Image size 2212x1659. FOV: 45 degrees: 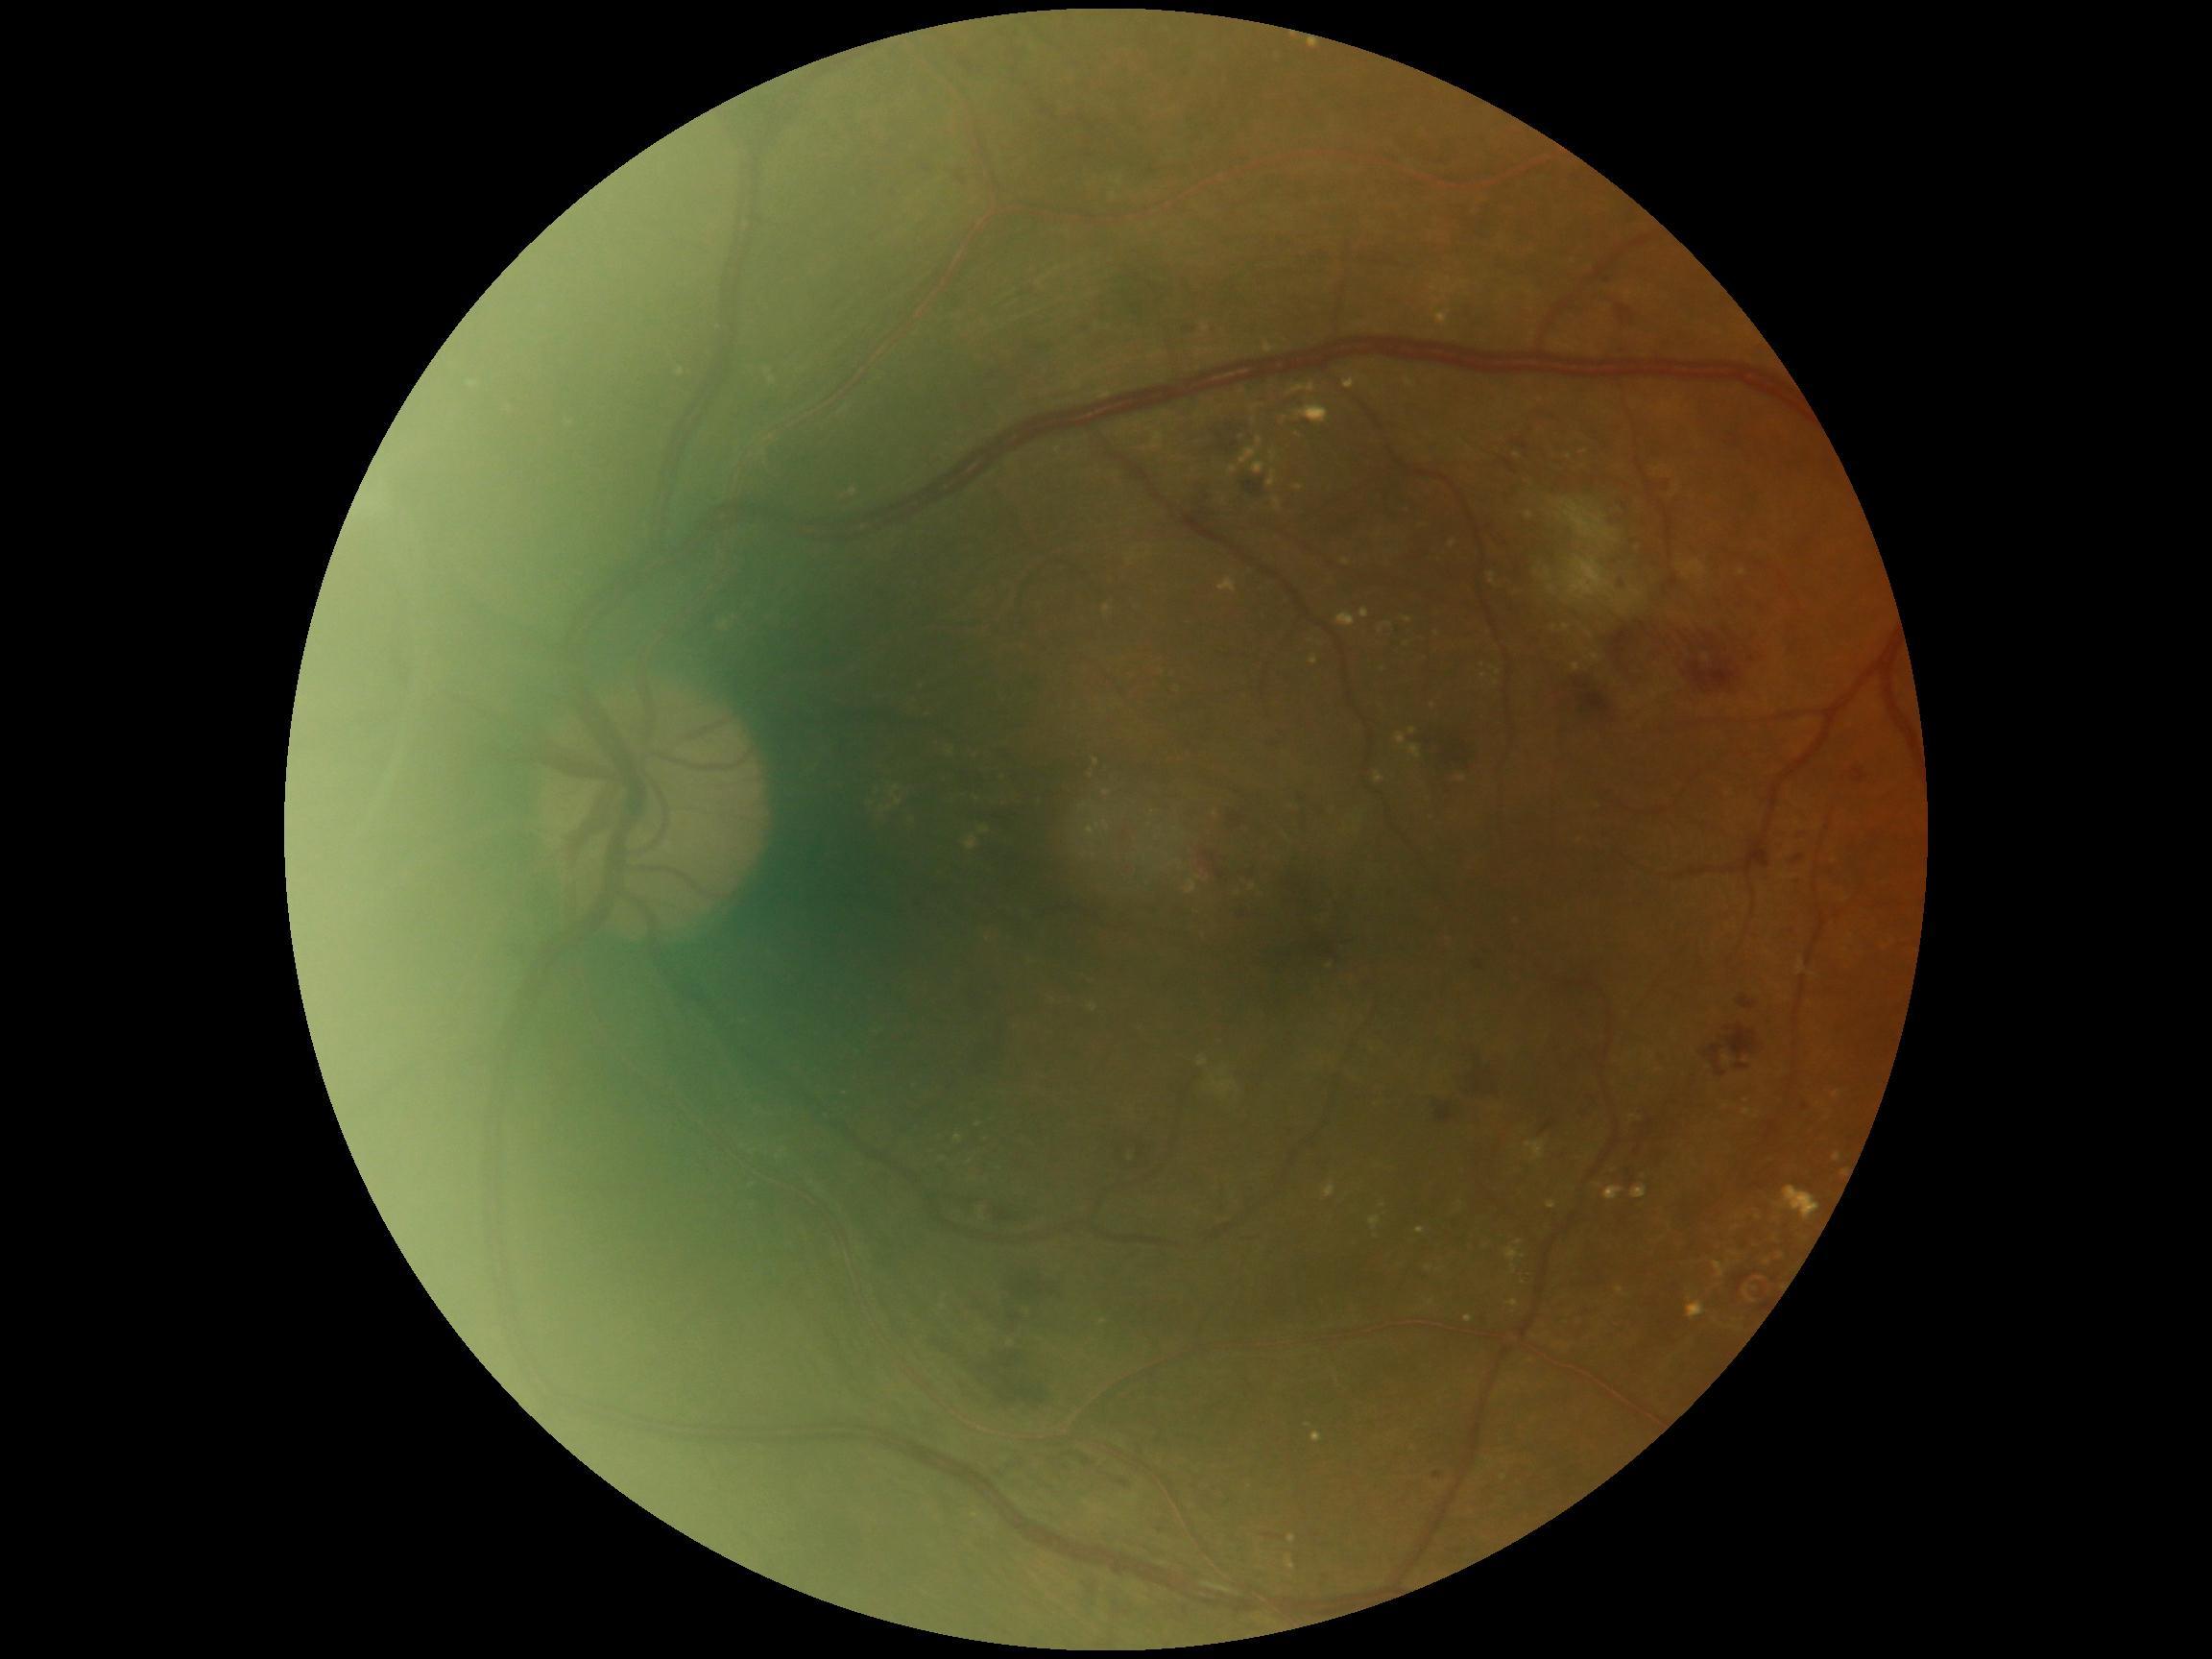 Diabetic retinopathy: grade 3.